Optic nerve head photograph · 322 by 322 pixels.
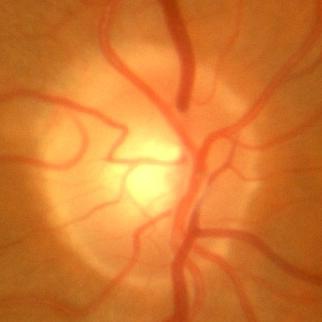 Optic disc appearance consistent with no signs of glaucoma.